CFP: 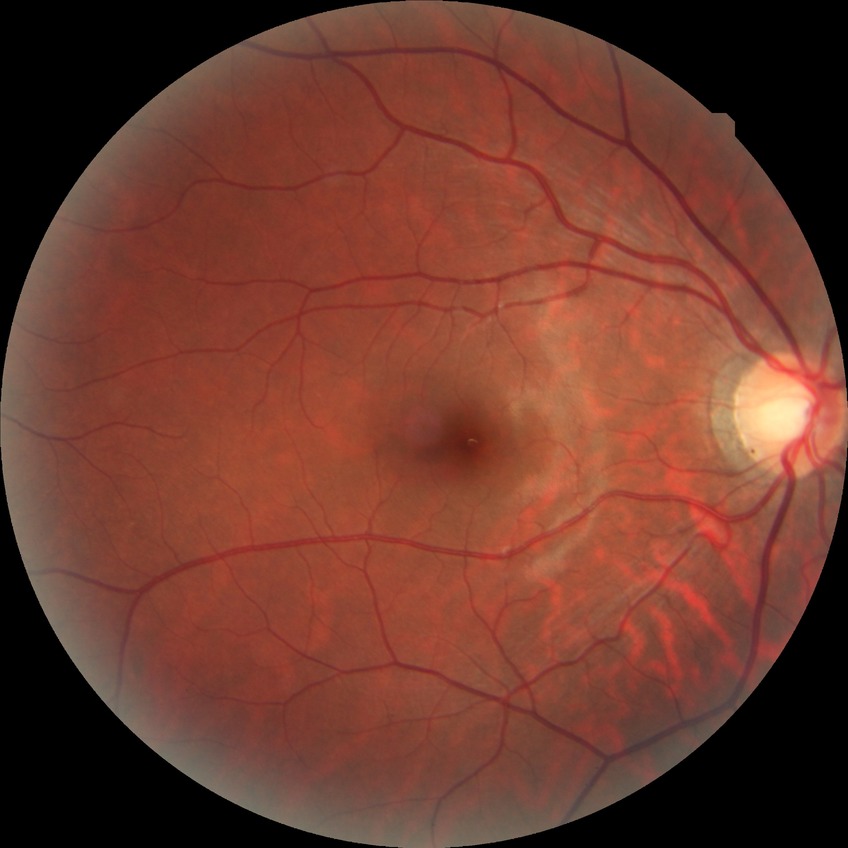 DR stage is NDR. No apparent diabetic retinopathy.